Acquired with a Topcon TRC-NW8, captured after pupil dilation:
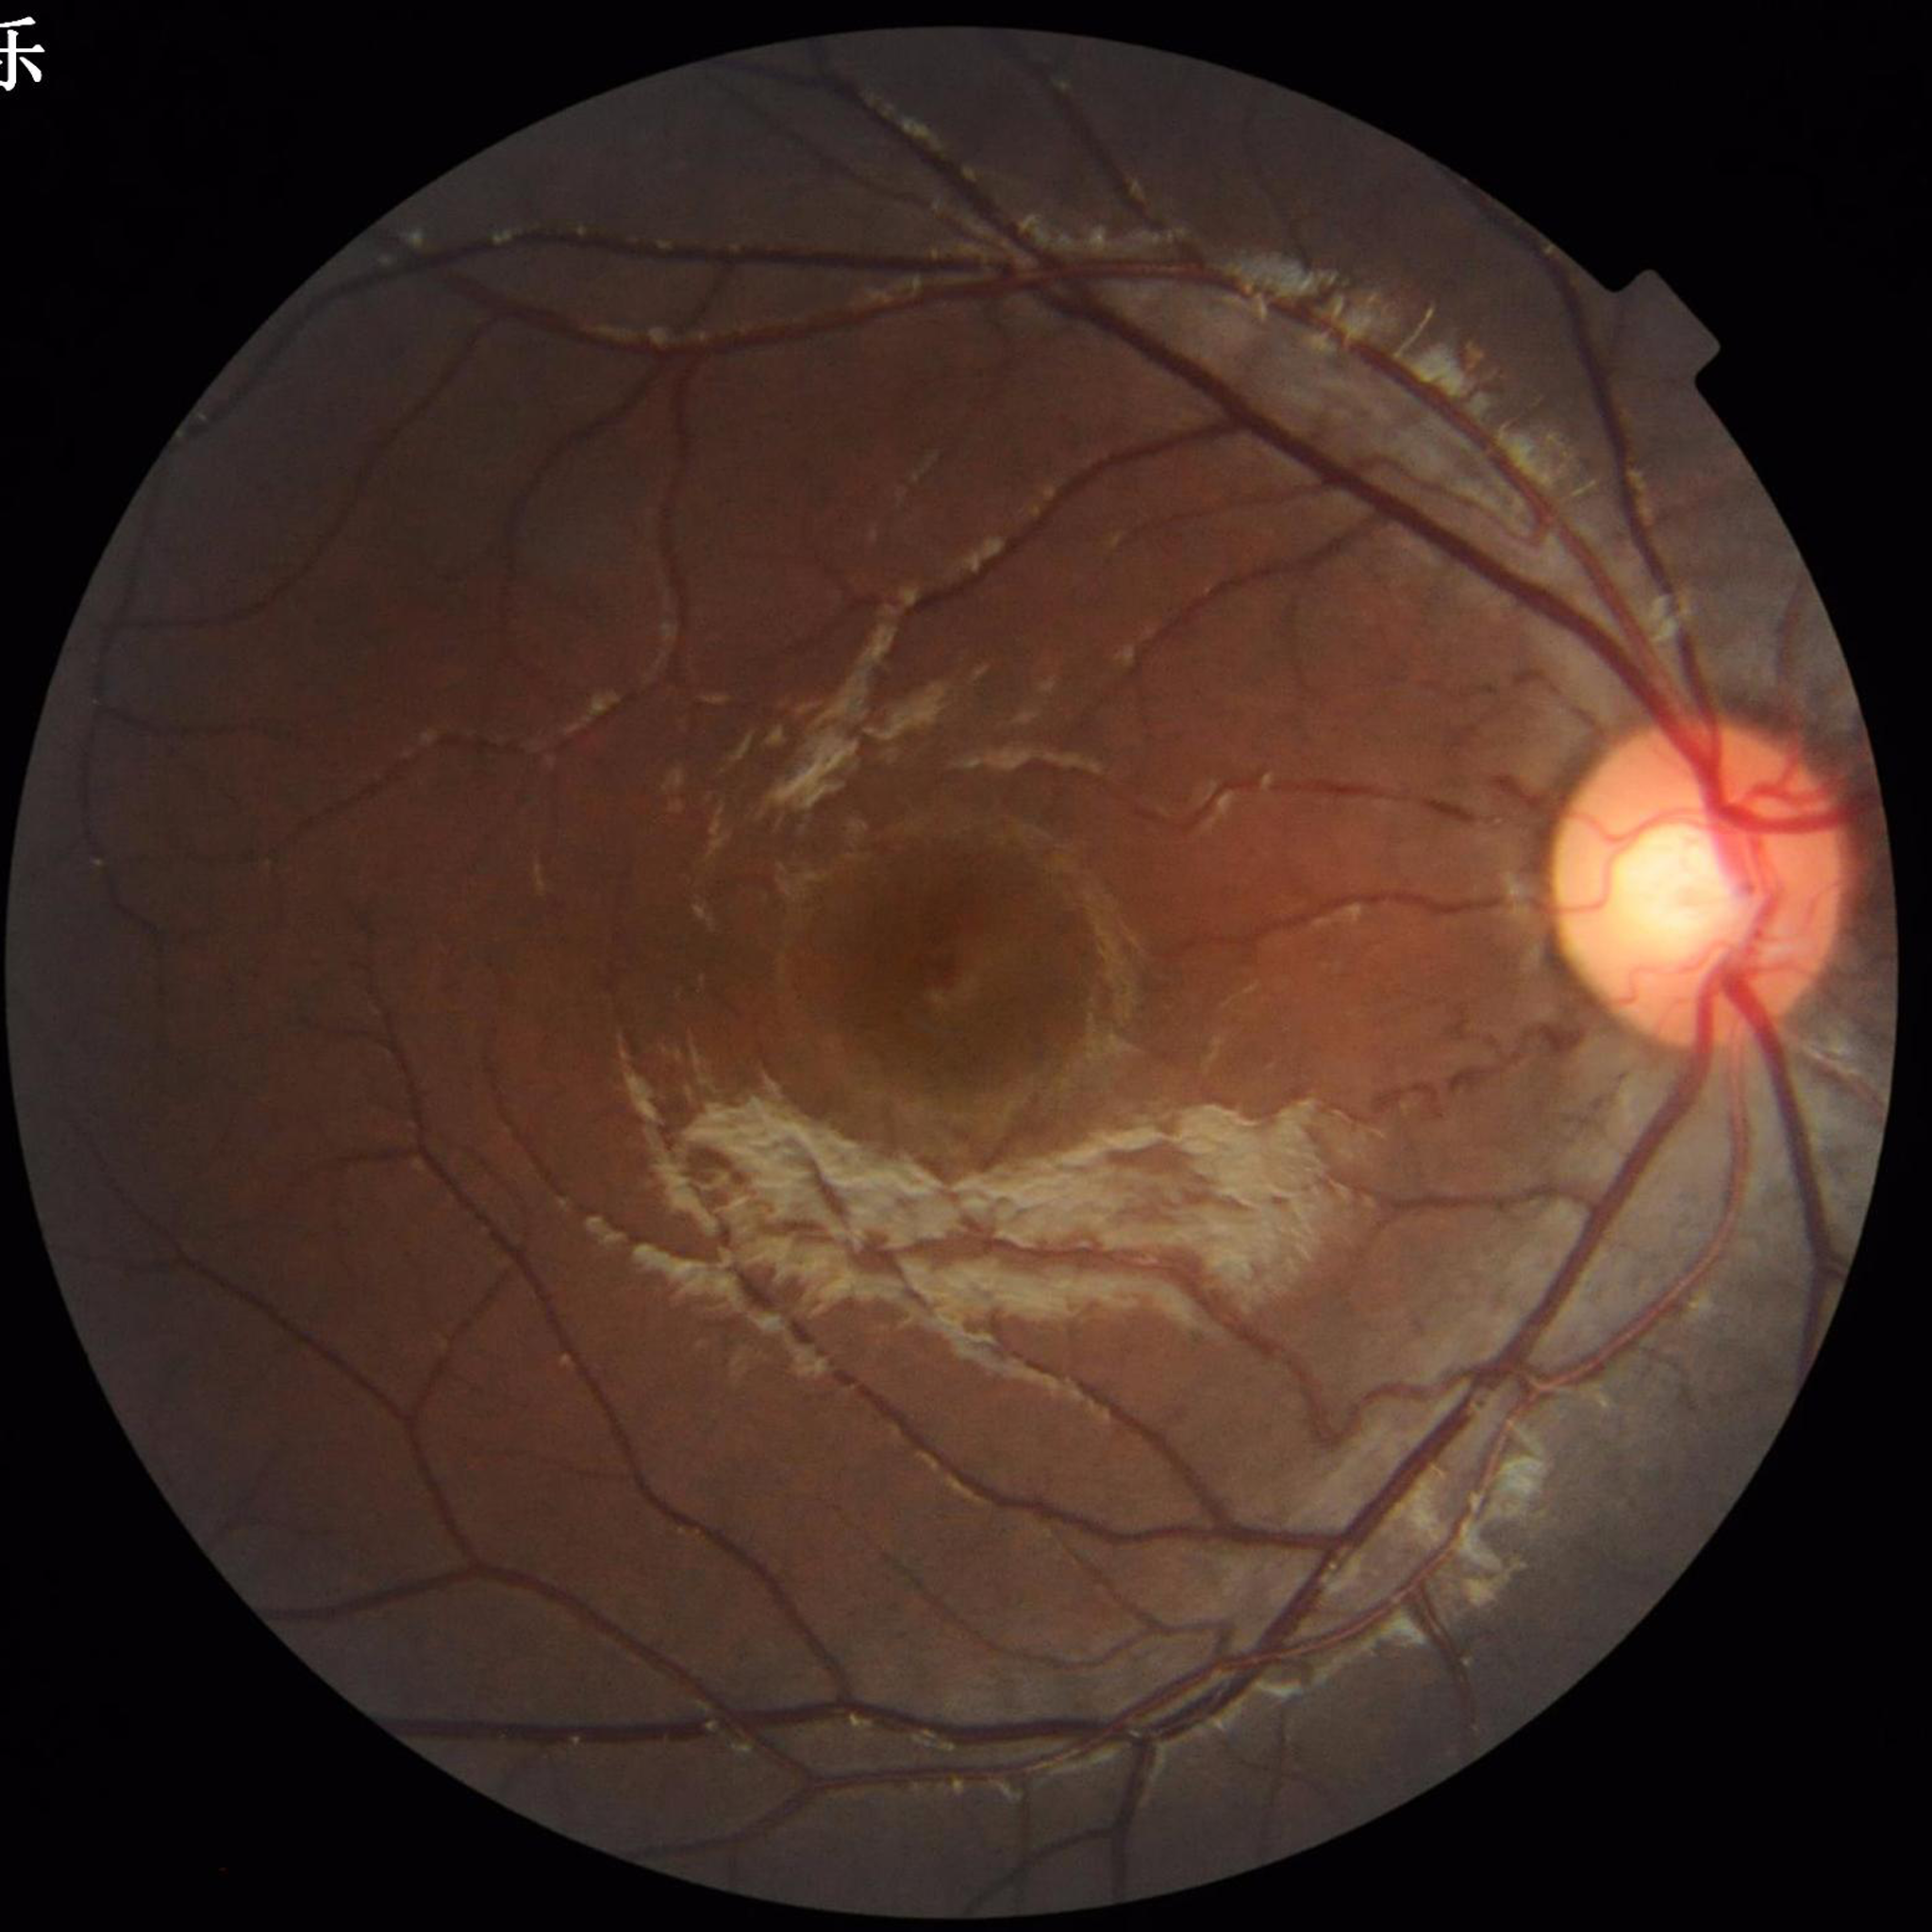

Quality: illumination and color satisfactory, no blur, contrast adequate | Disease: no AMD, diabetic retinopathy, or glaucoma.